FOV: 45 degrees
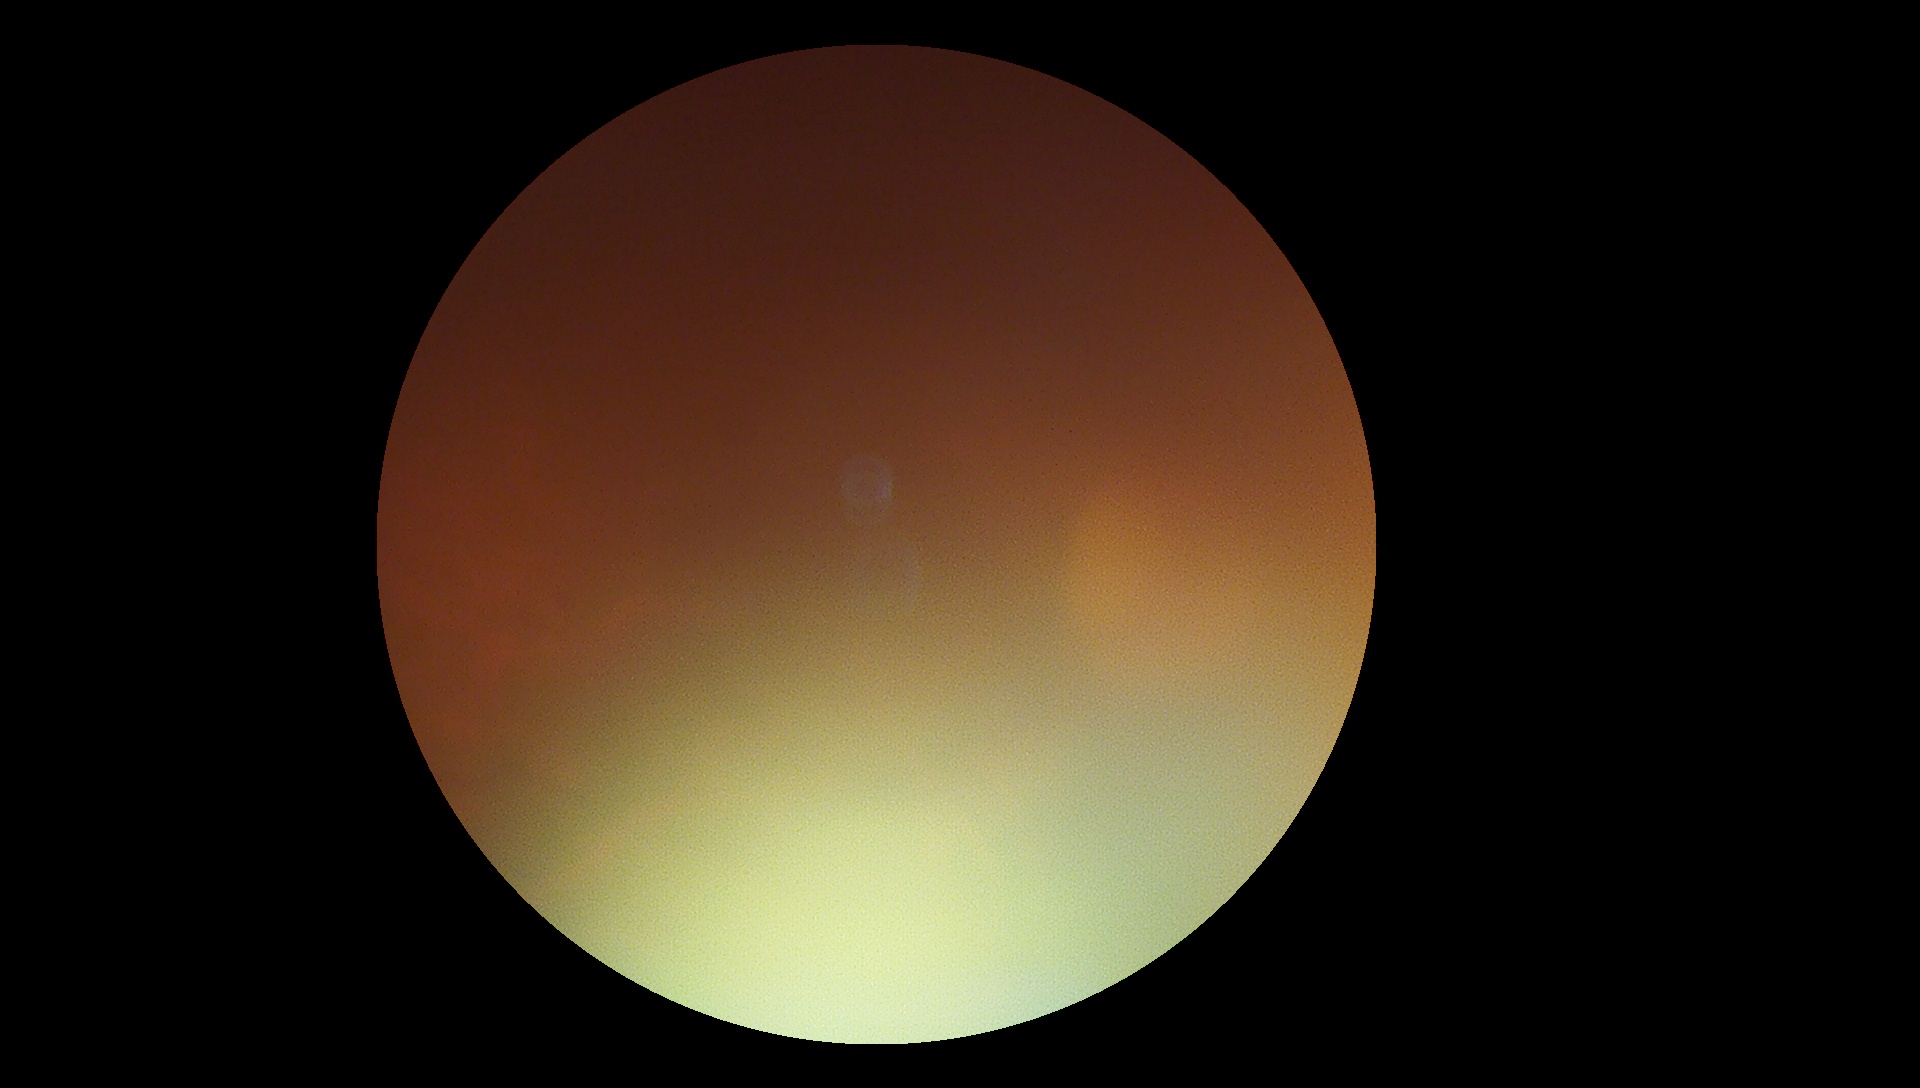
diabetic retinopathy=ungradable due to poor image quality.